848 by 848 pixels · 45-degree field of view · NIDEK AFC-230 fundus camera · color fundus photograph
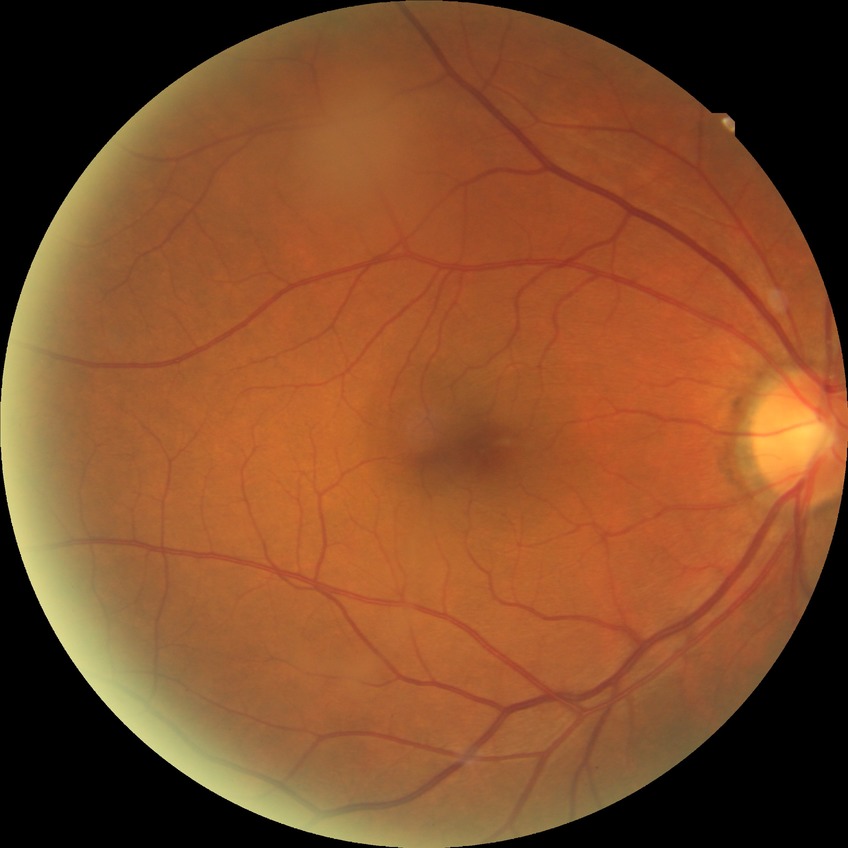 {
  "davis_grade": "NDR (no diabetic retinopathy)"
}